NIDEK AFC-230 fundus camera.
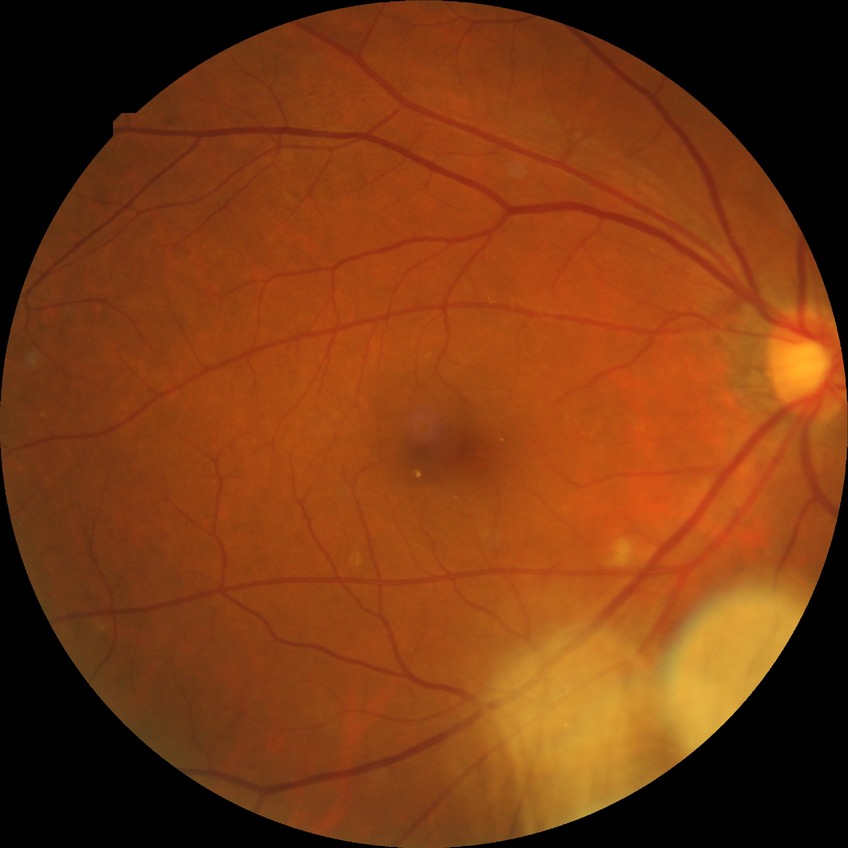

modified Davis classification=simple diabetic retinopathy.